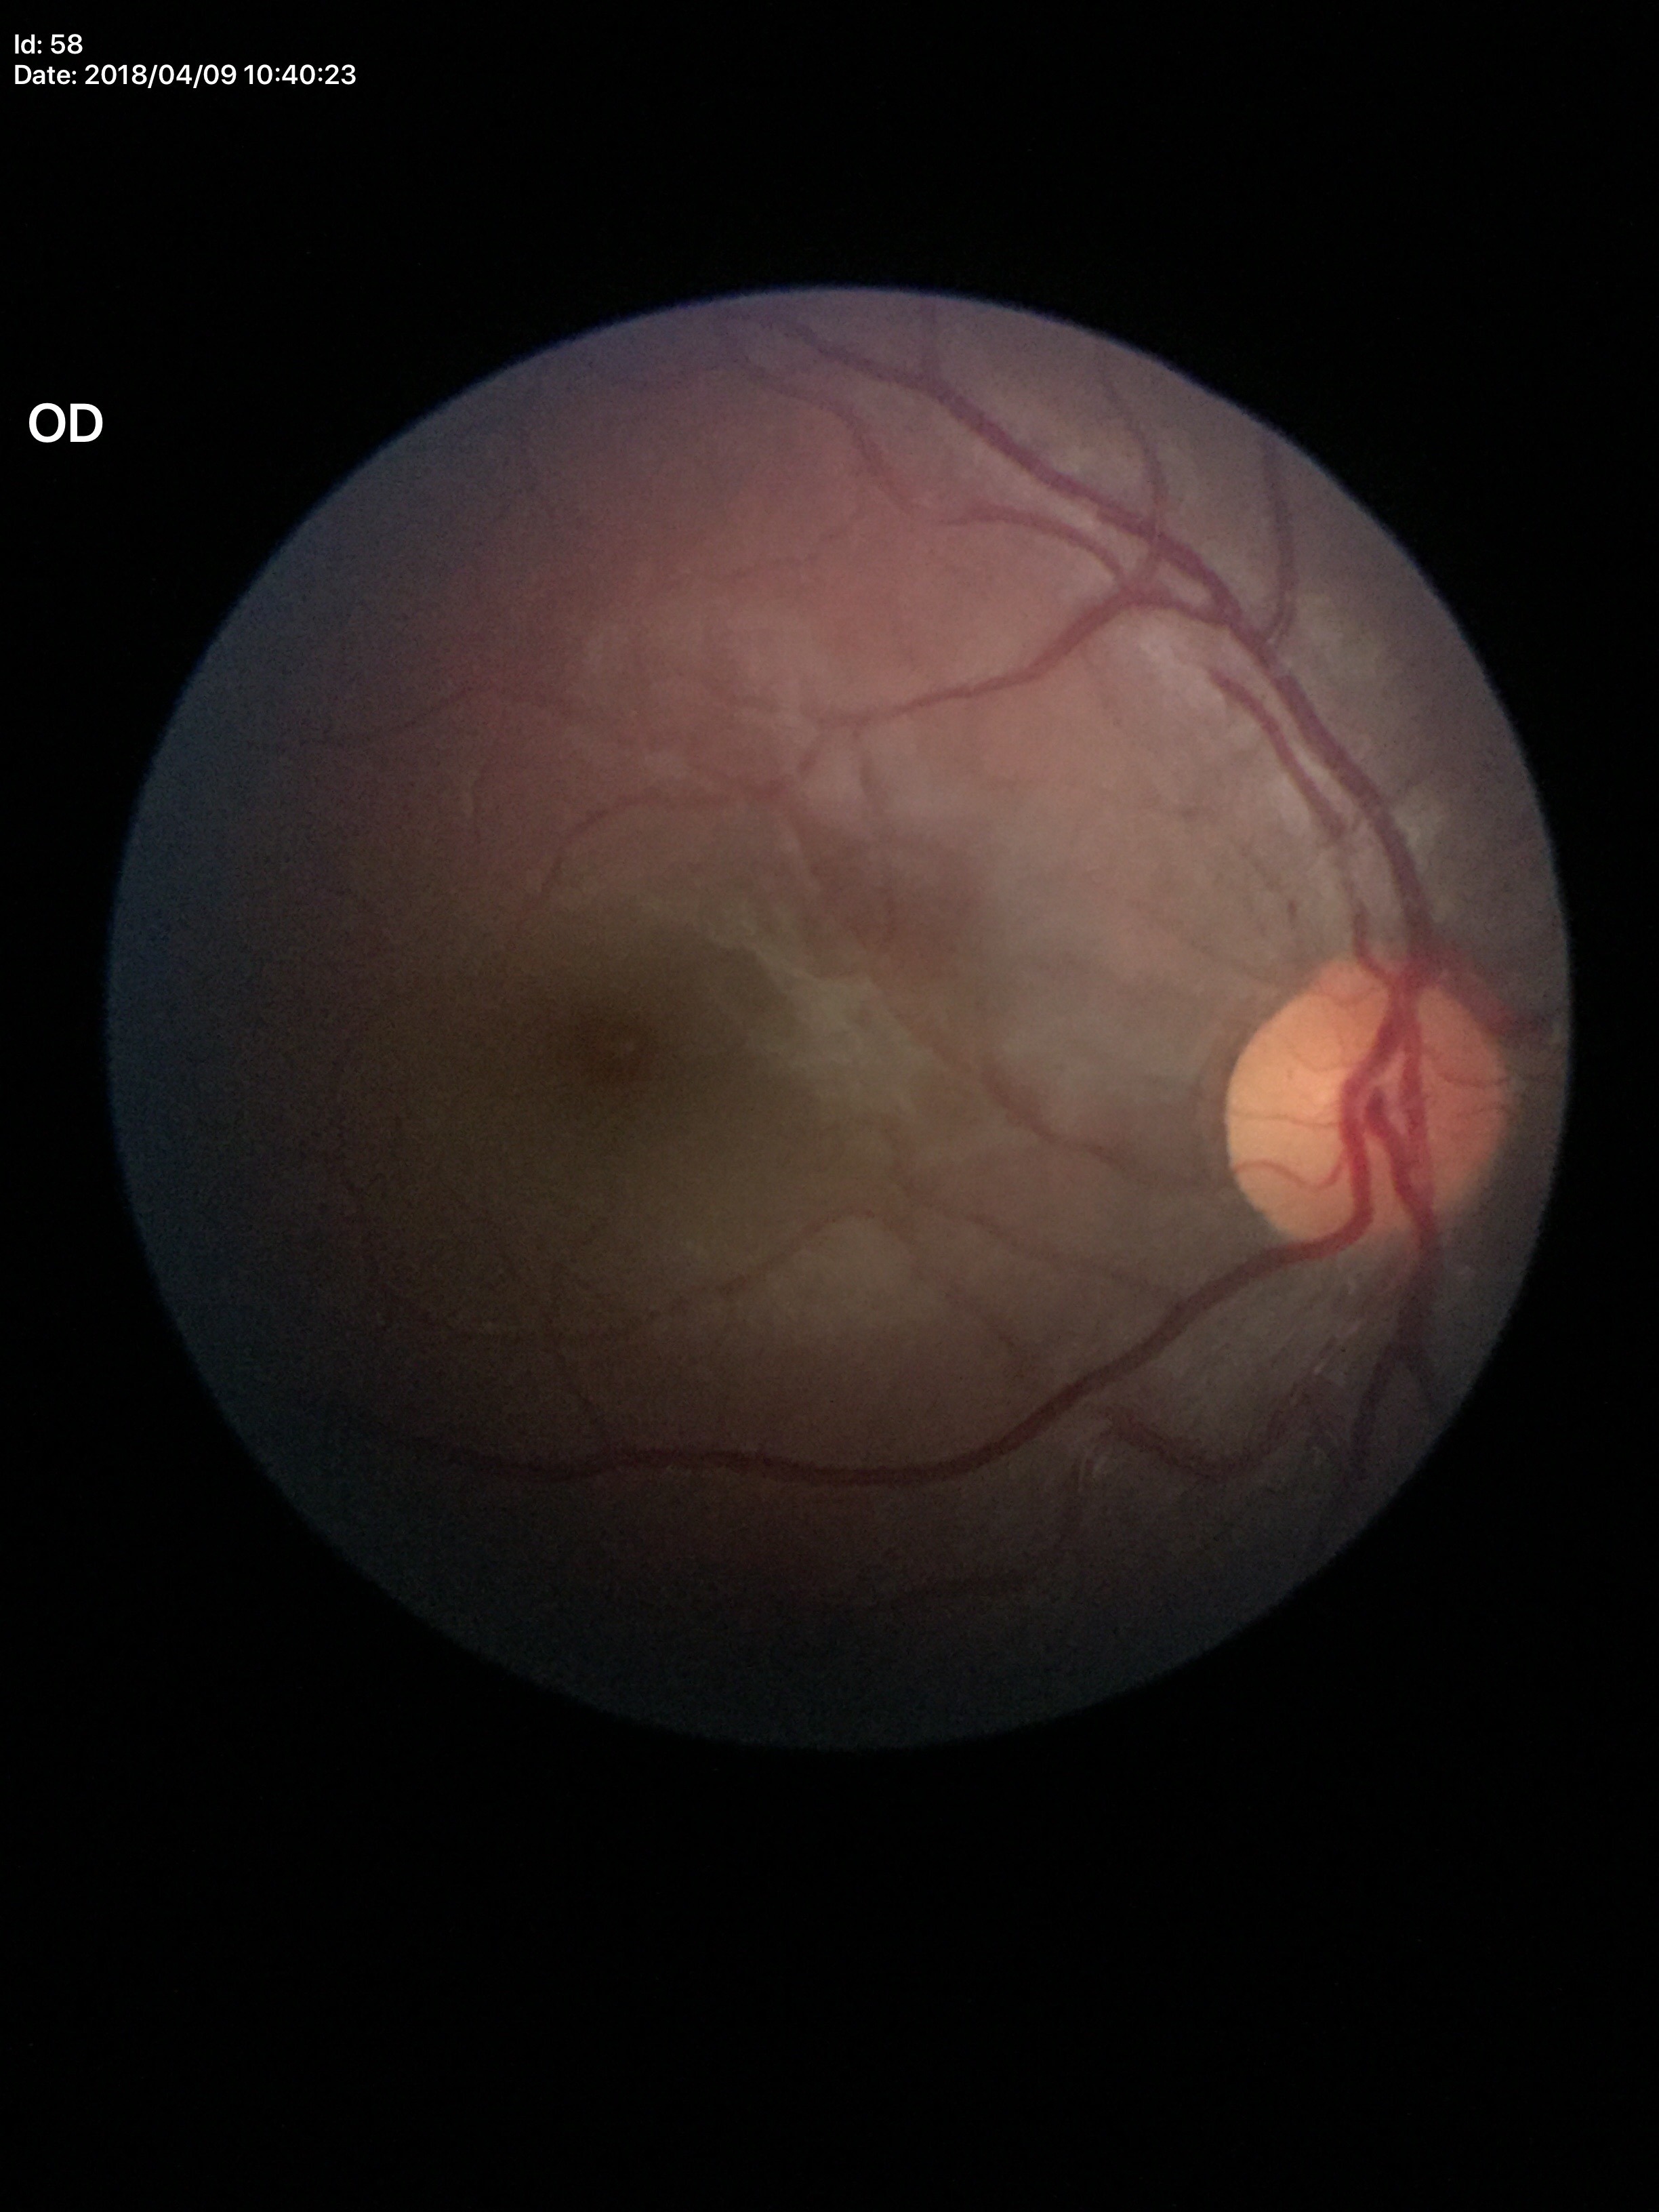

VCDR: 0.44, Glaucoma evaluation: not suspect.